Color fundus photograph; 45° FOV; image size 2212x1659.
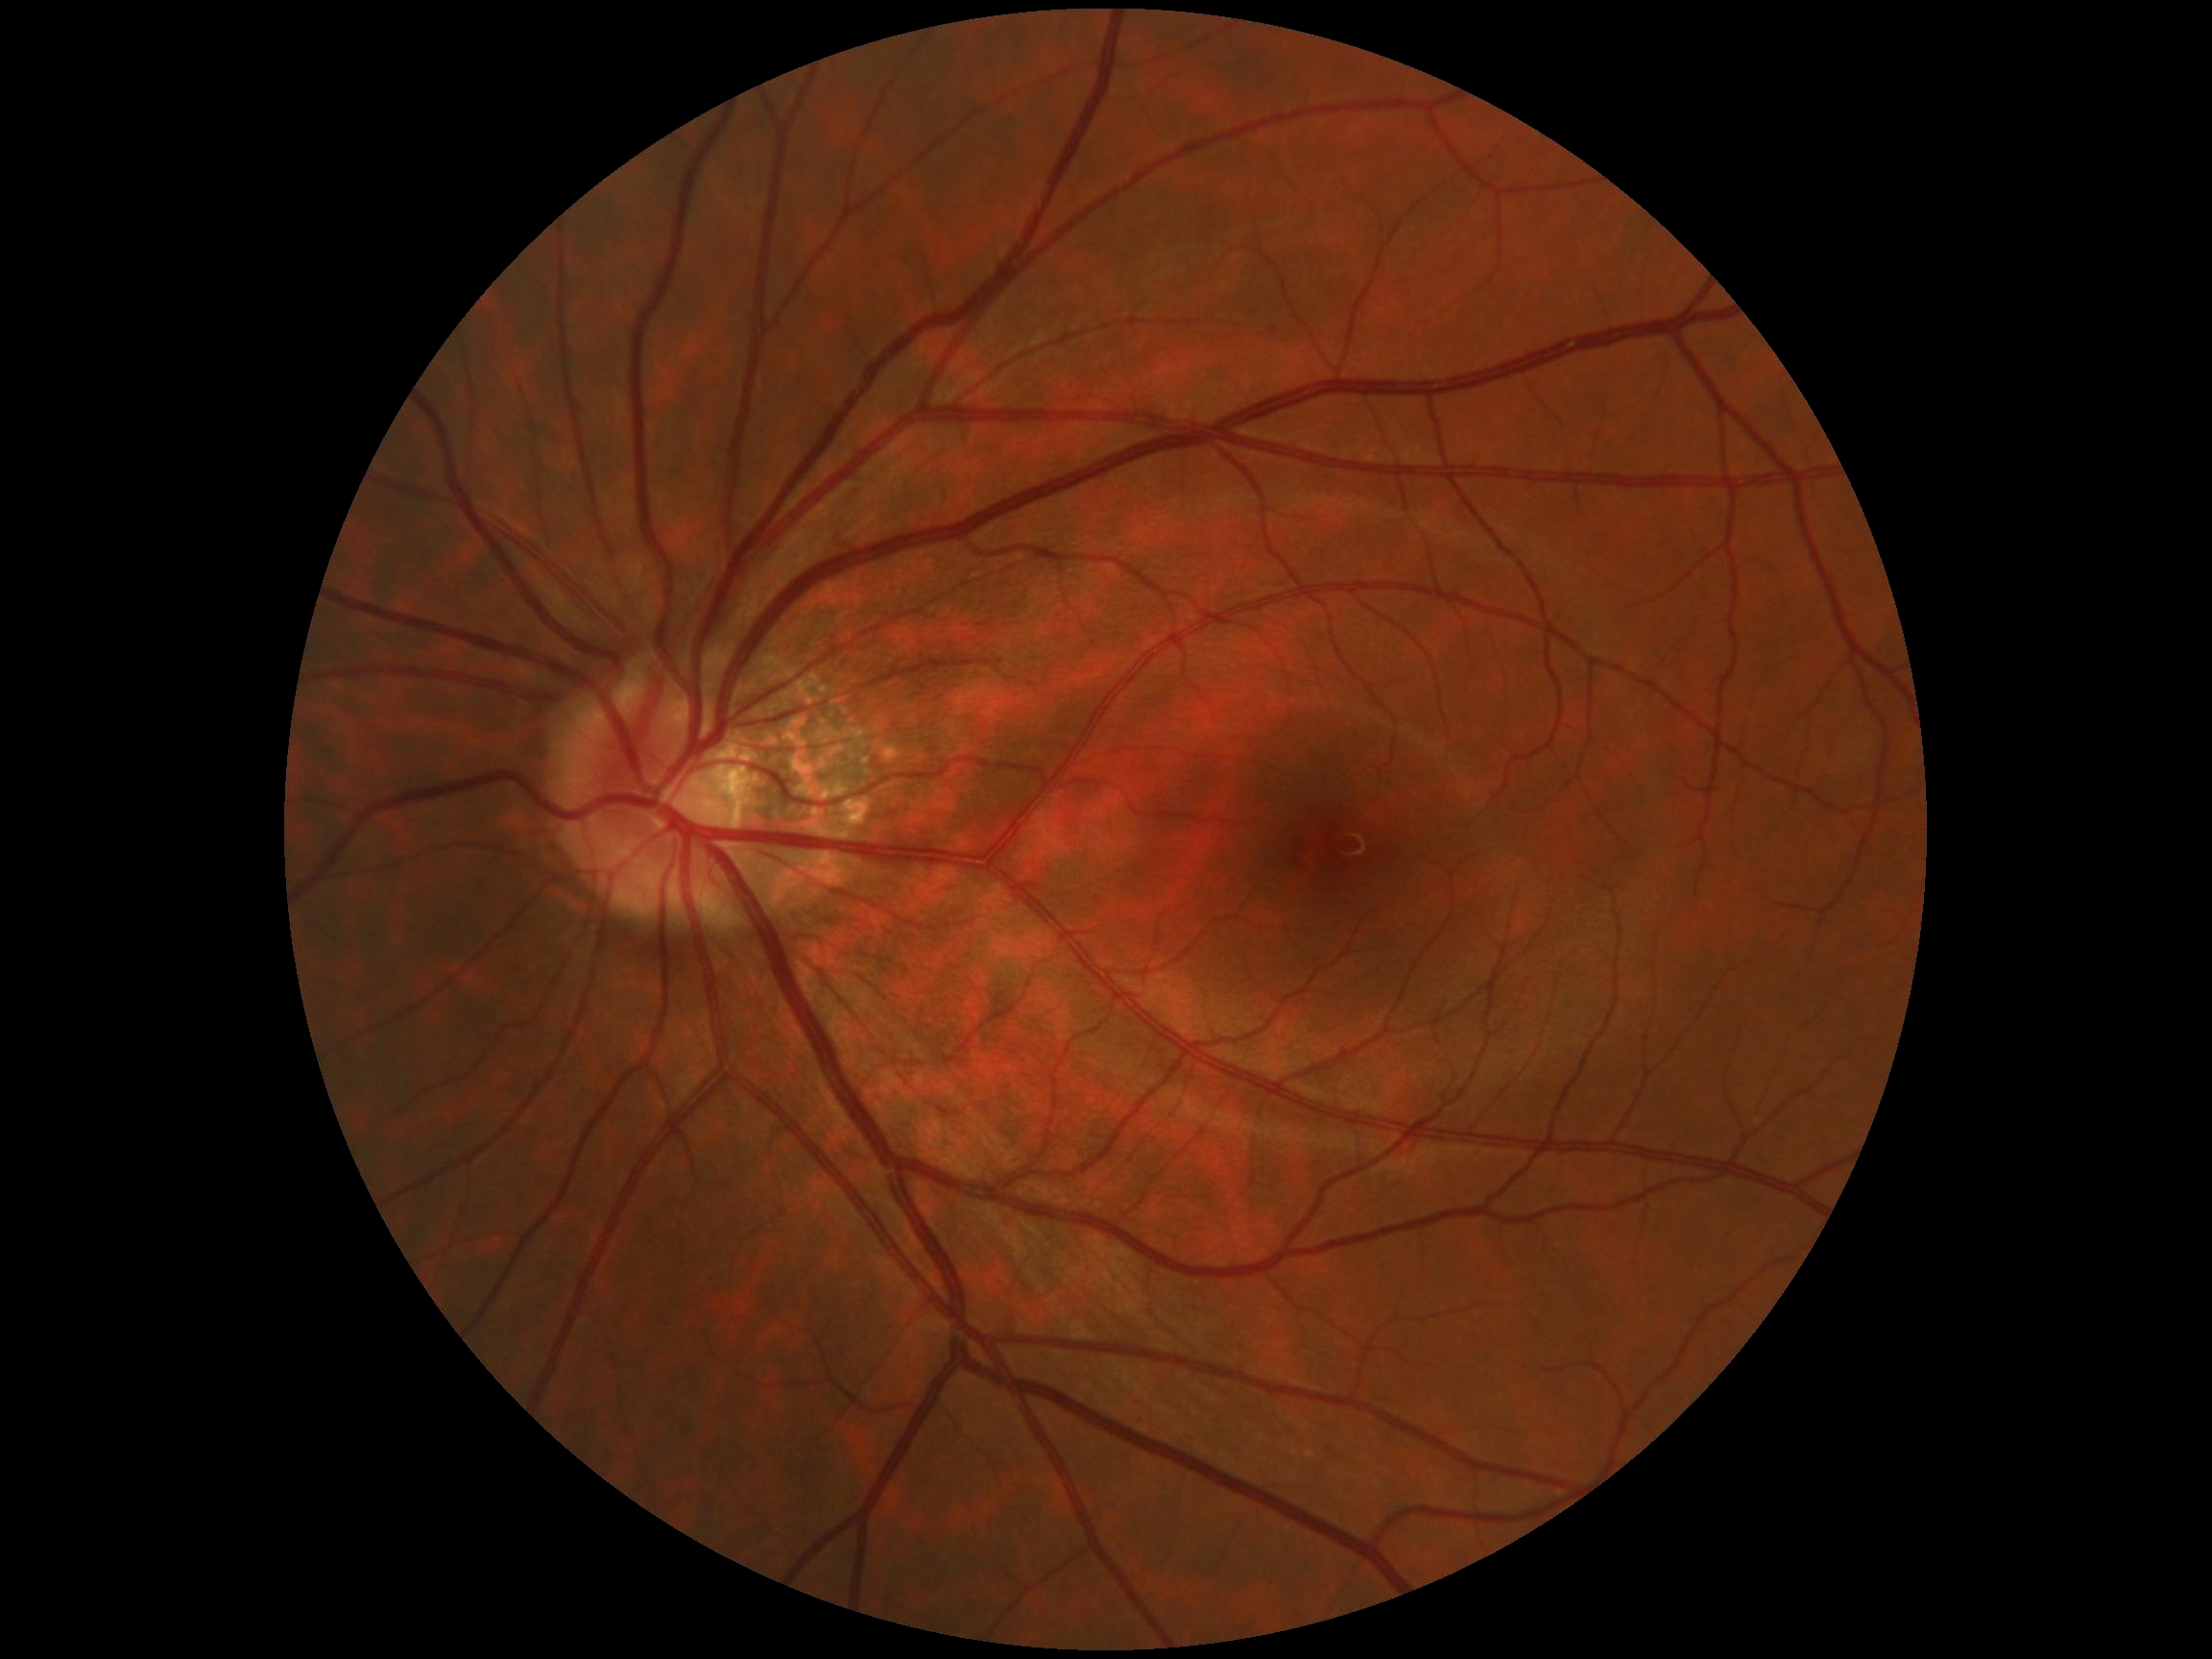

Diabetic retinopathy grade is 0/4.